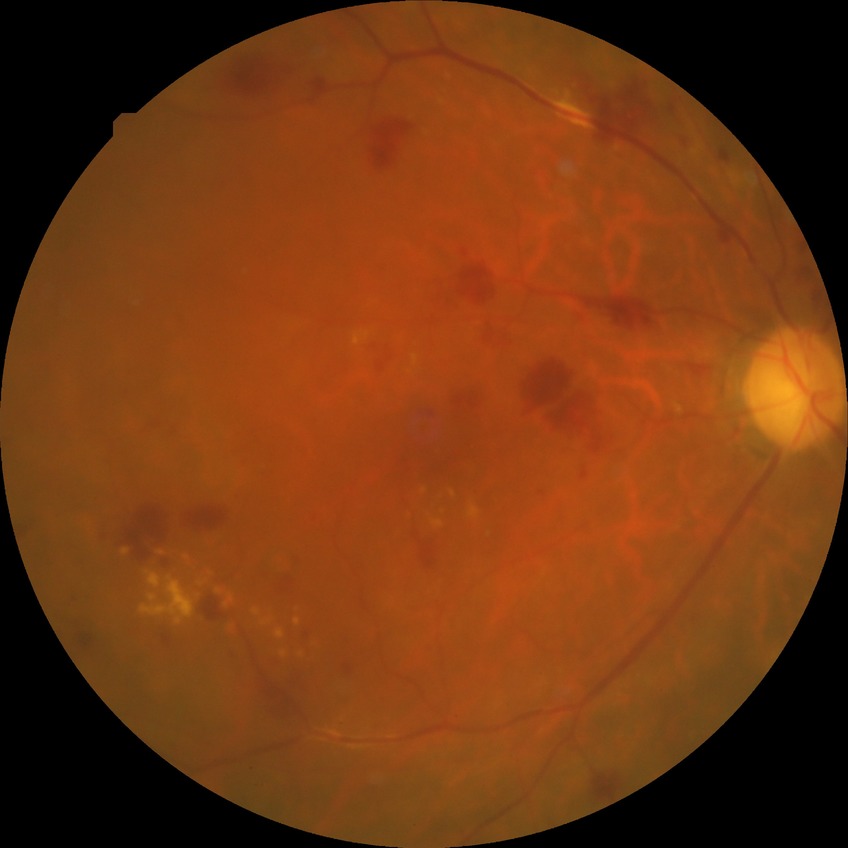 Diabetic retinopathy (DR): PPDR (pre-proliferative diabetic retinopathy).